Image size 512x512
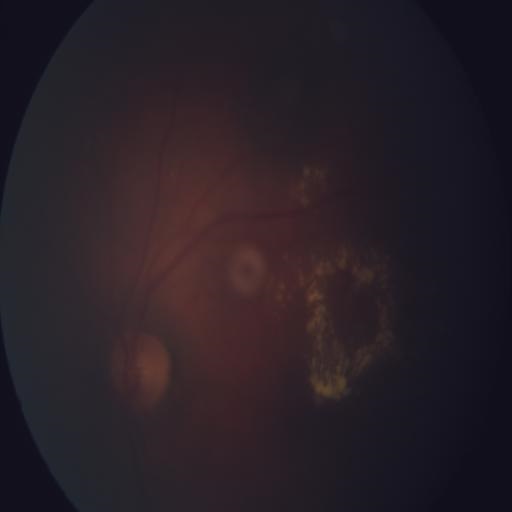

Abnormalities:
- exudation
- media haze